Modified Davis grading:
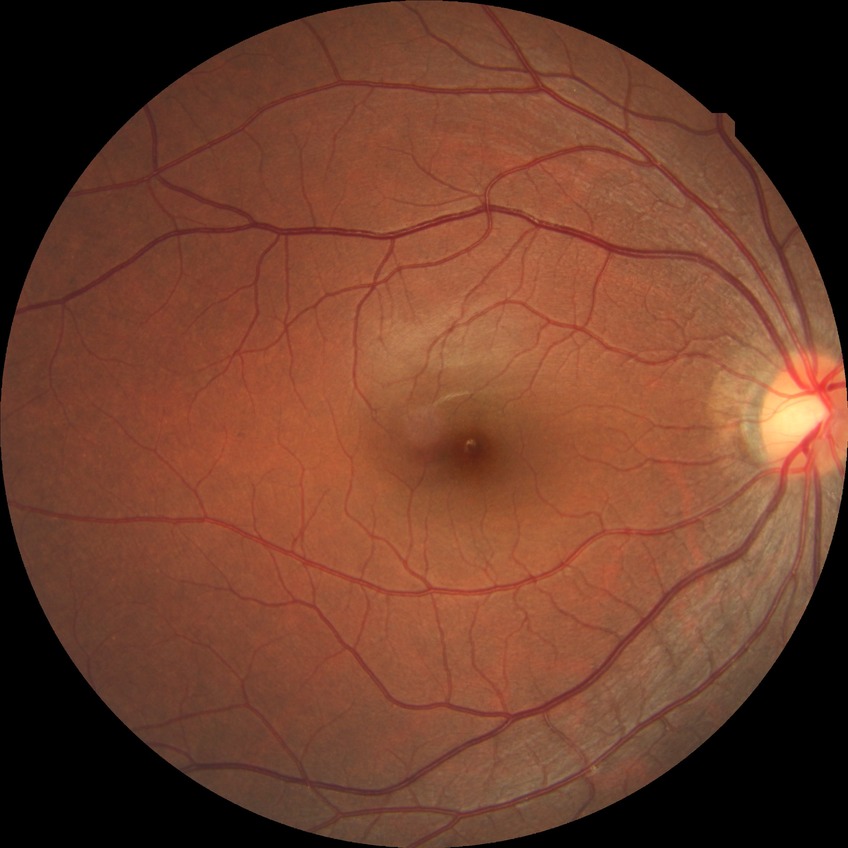 DR severity: NDR.